Fundus photograph cropped around the optic nerve head:
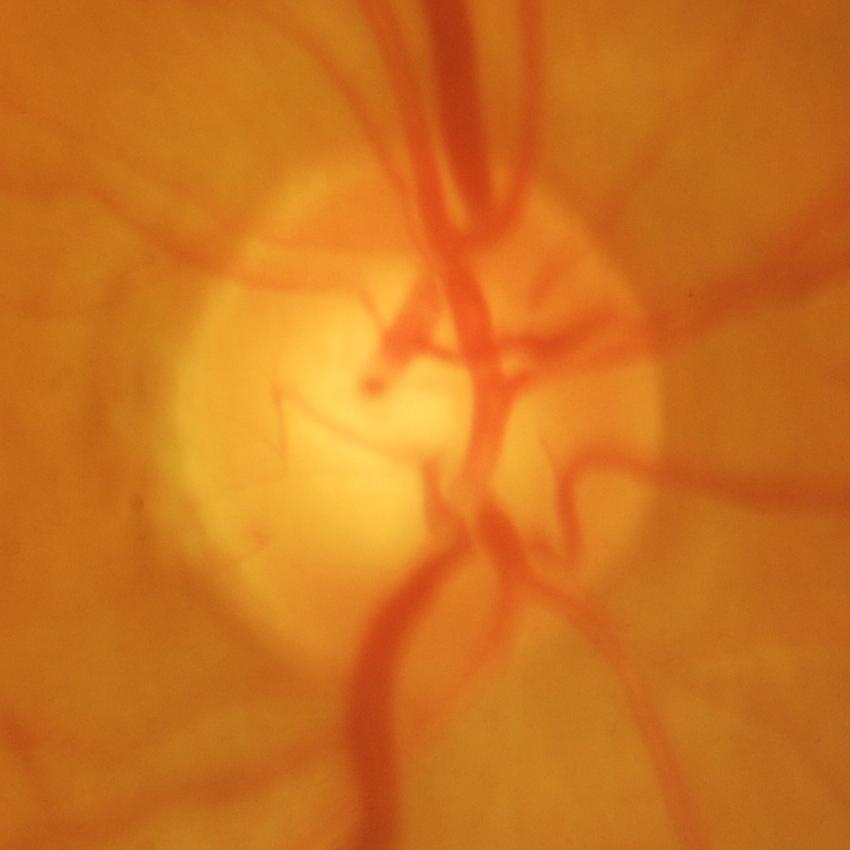 Diagnosis = glaucomatous changes.